Wide-field fundus image from infant ROP screening:
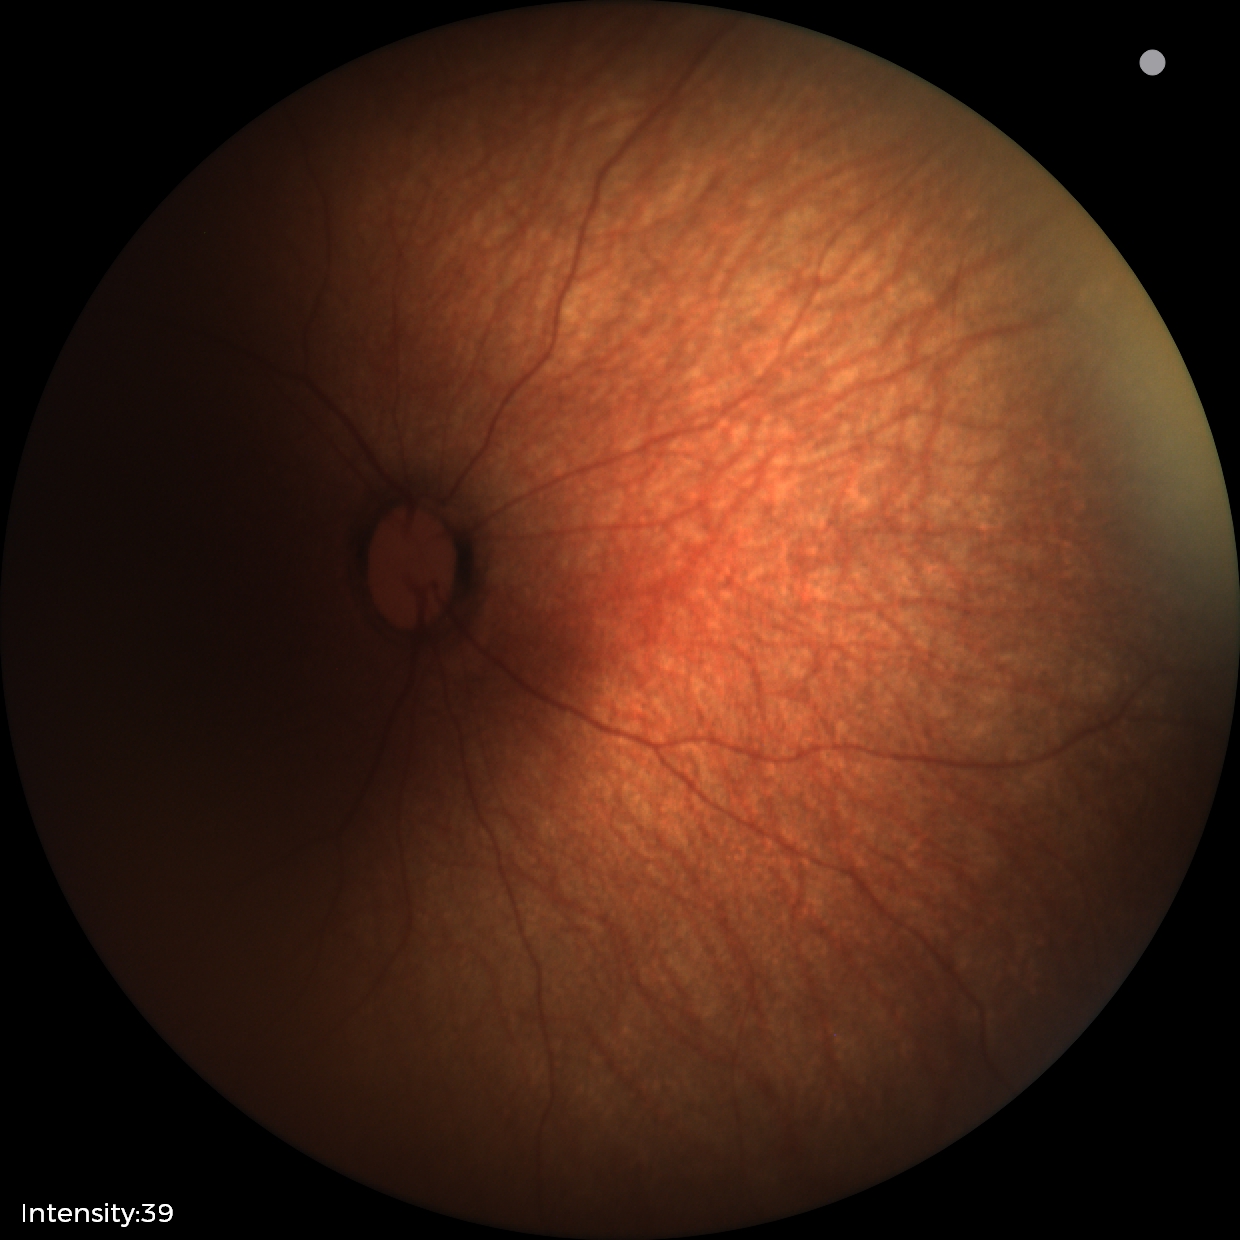
Impression = normal retinal appearance.